Nonmydriatic fundus photograph — 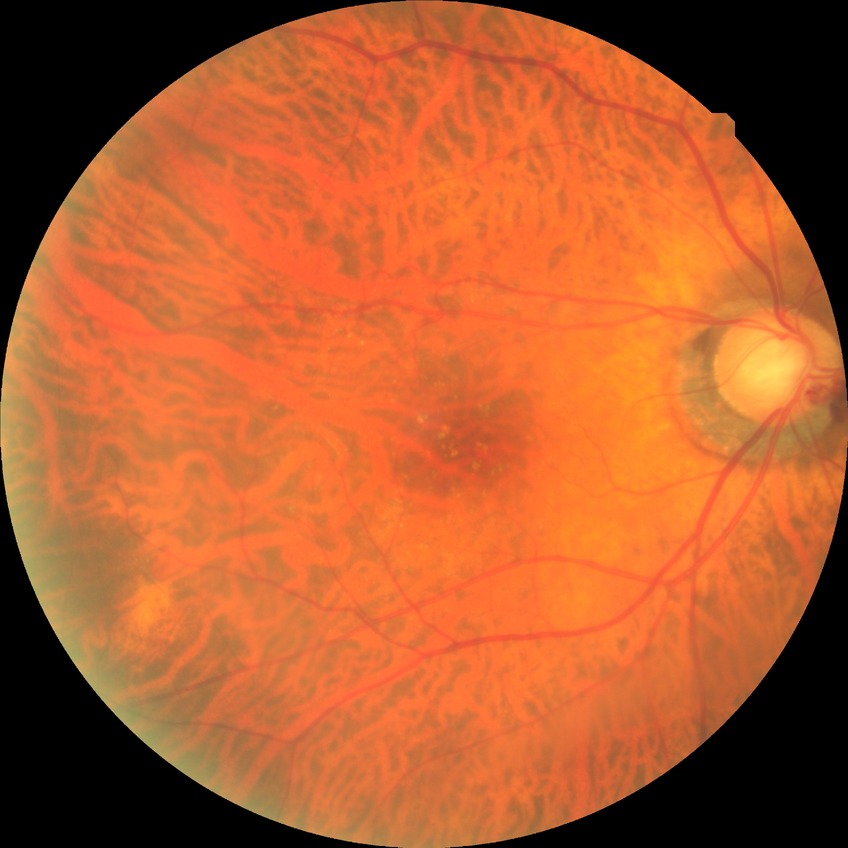
– Davis stage: NDR